2352x1568, color fundus photograph
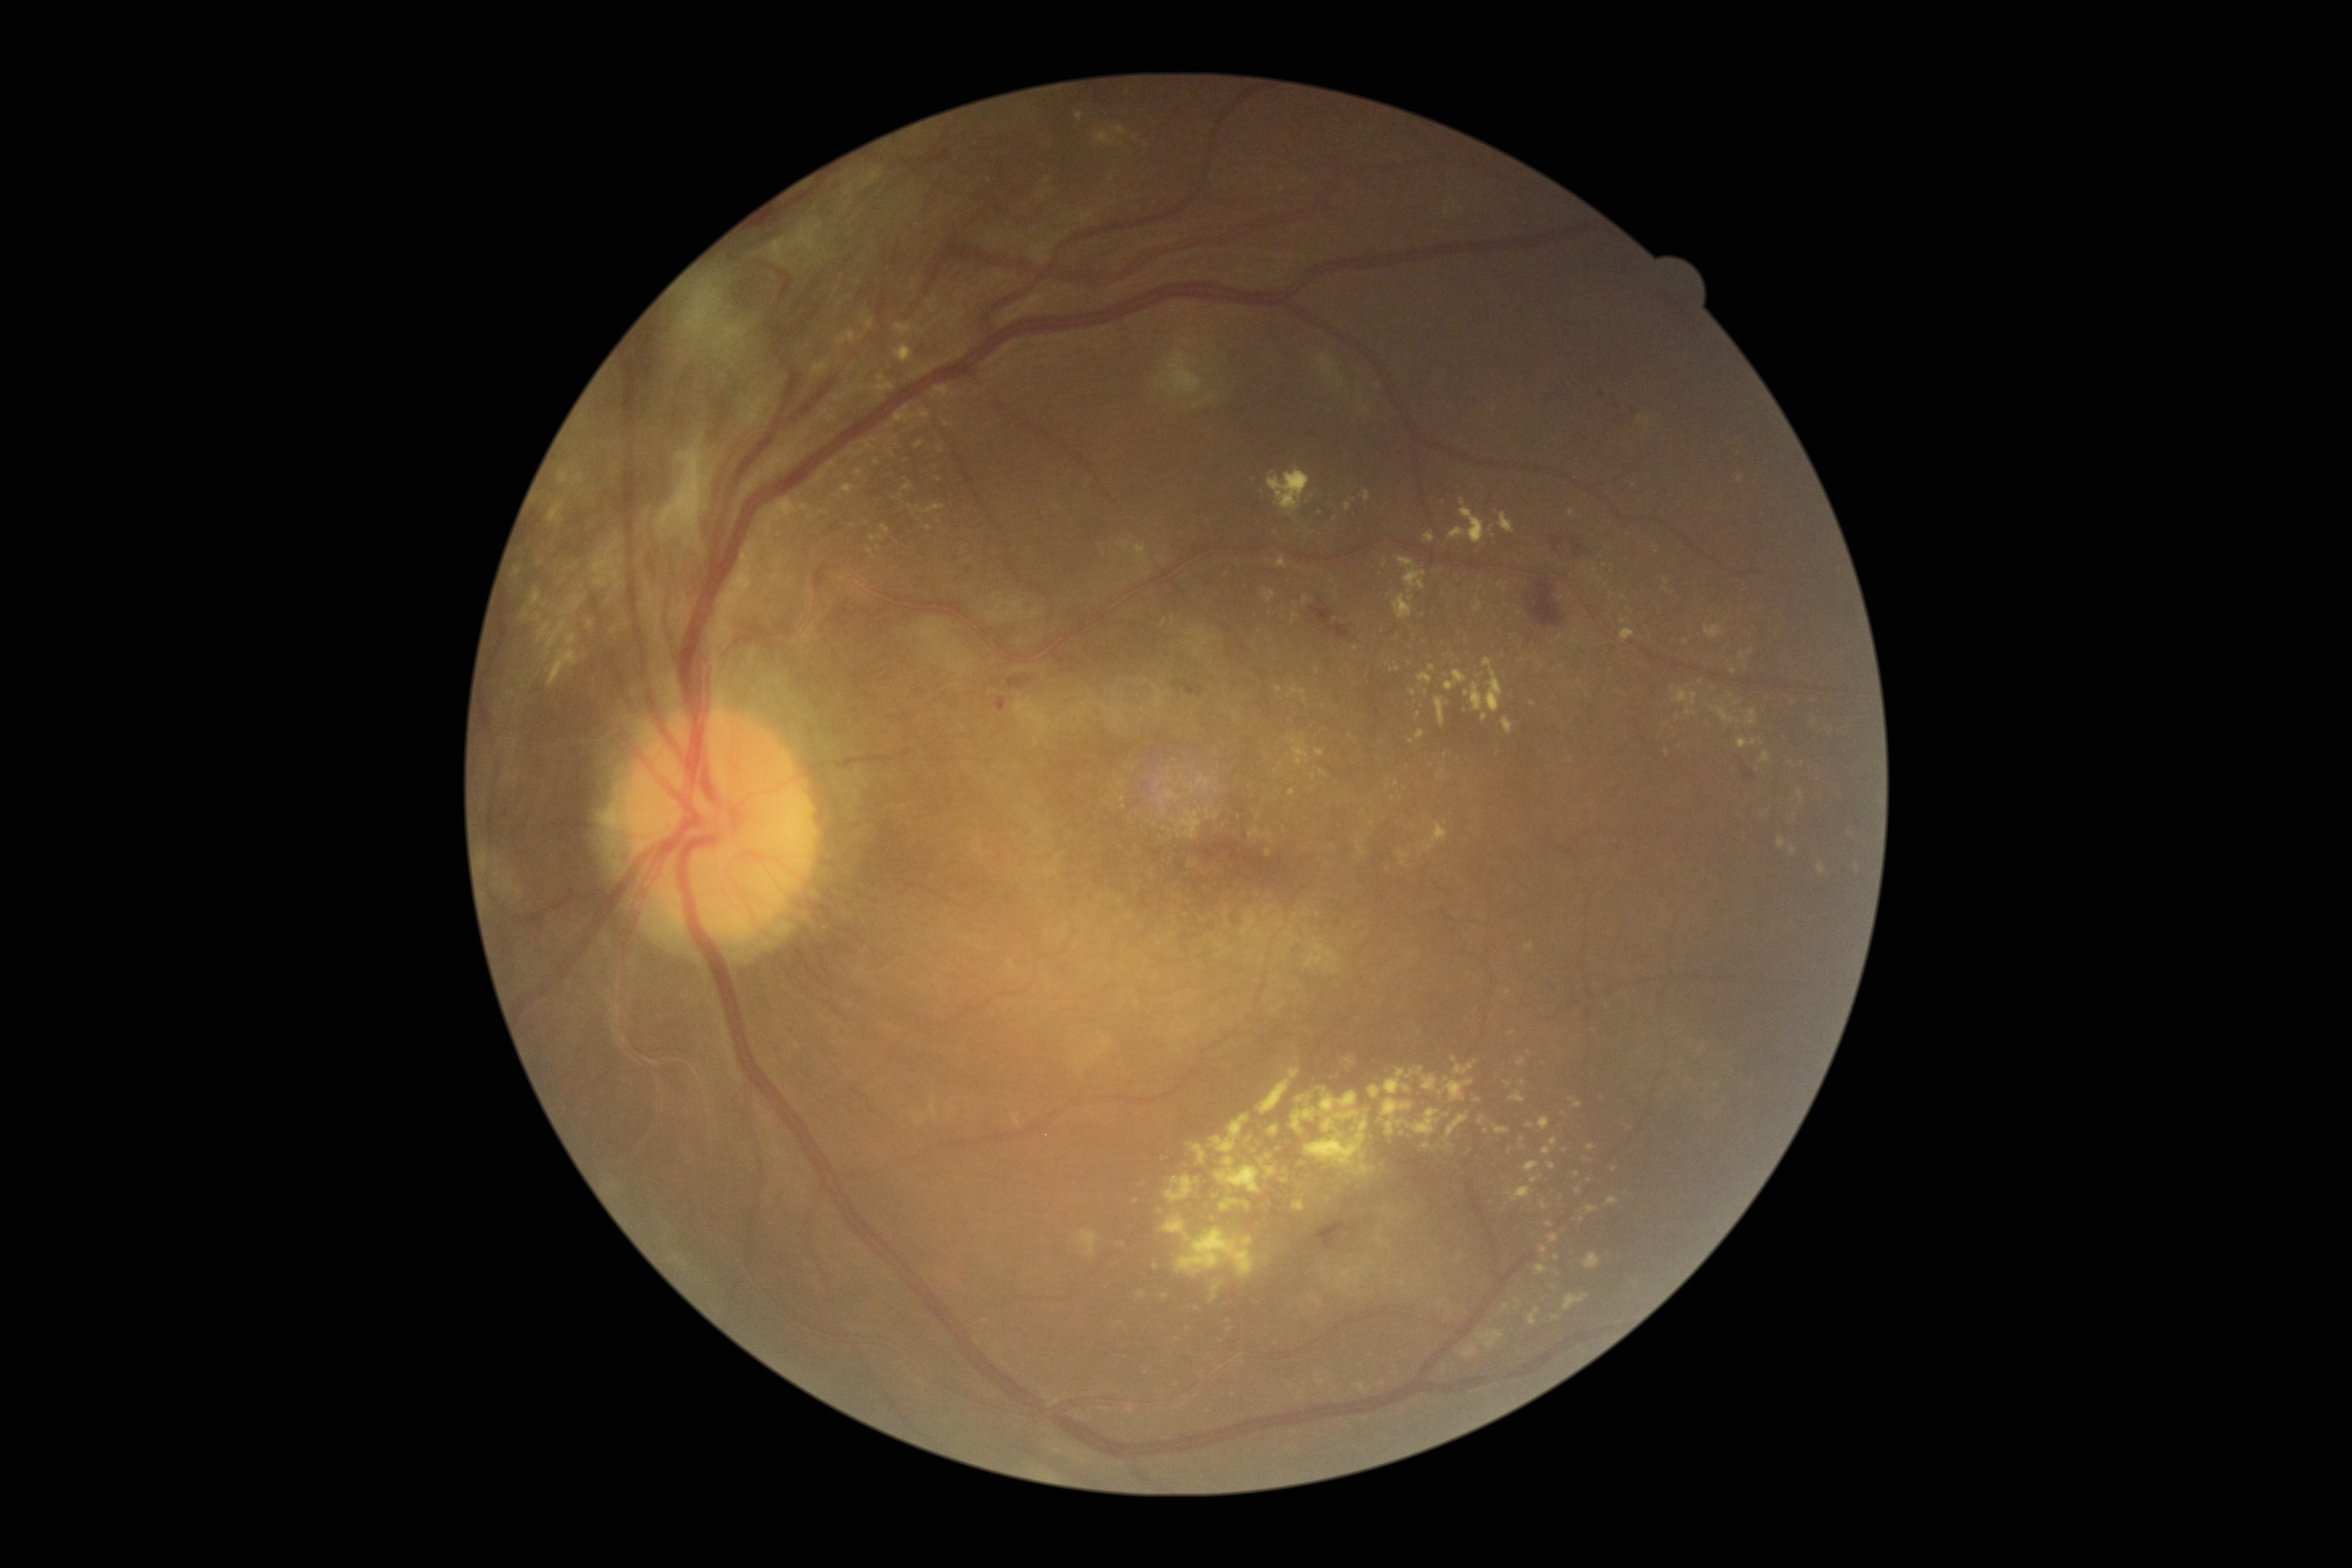

Diabetic retinopathy (DR): grade 4 (PDR).
Hard exudates (EXs) (partial list) at bbox=[1423, 1144, 1431, 1148], bbox=[1075, 112, 1083, 122], bbox=[889, 436, 898, 442], bbox=[1460, 1342, 1479, 1358], bbox=[1746, 710, 1759, 727], bbox=[1548, 1162, 1557, 1171], bbox=[1385, 1069, 1413, 1094], bbox=[1452, 1058, 1478, 1075], bbox=[862, 441, 874, 451], bbox=[1354, 1382, 1364, 1387], bbox=[1209, 1112, 1249, 1154], bbox=[1264, 589, 1275, 602].
Small EXs approximately at [1565,1150], [1419,714], [1586,1159], [1523,1082], [1389,595], [939,480], [1285,1180].